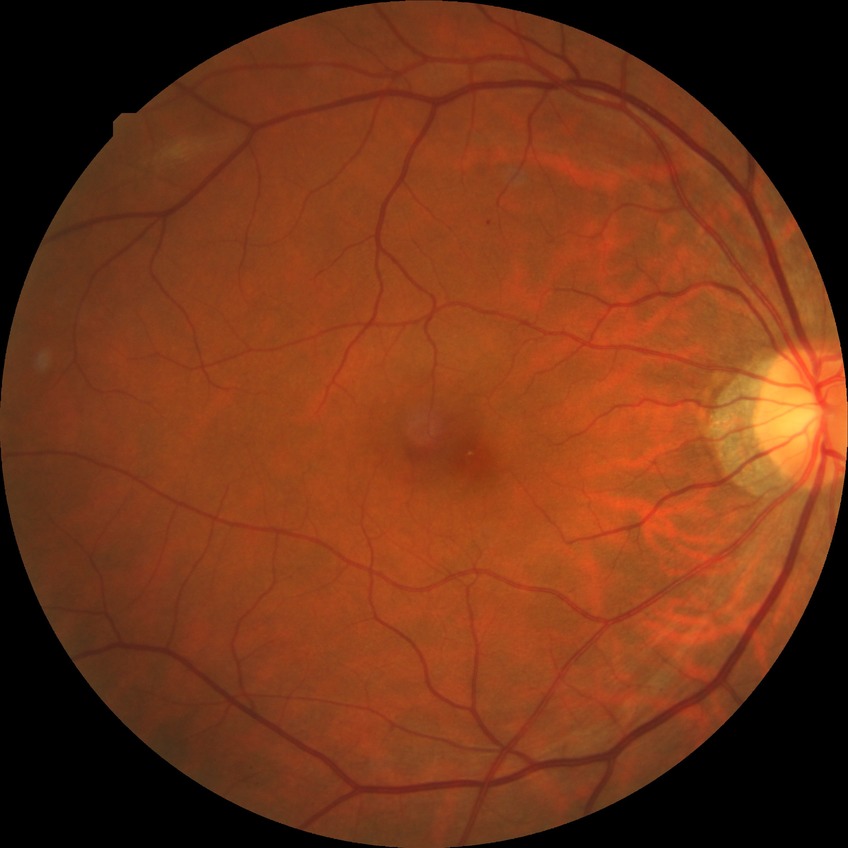 Retinopathy grade is simple diabetic retinopathy.